512 x 512 pixels.
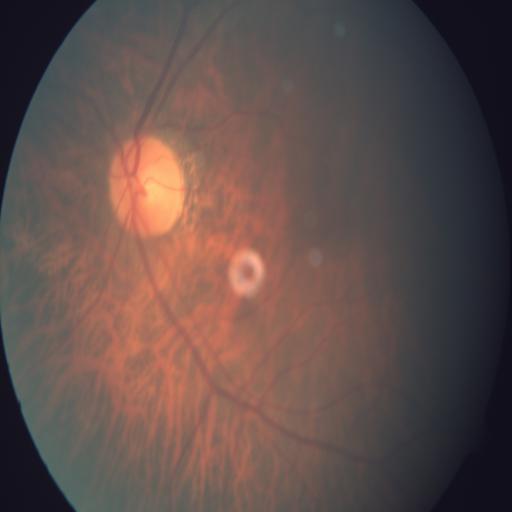 Fundus image with findings of tessellation.